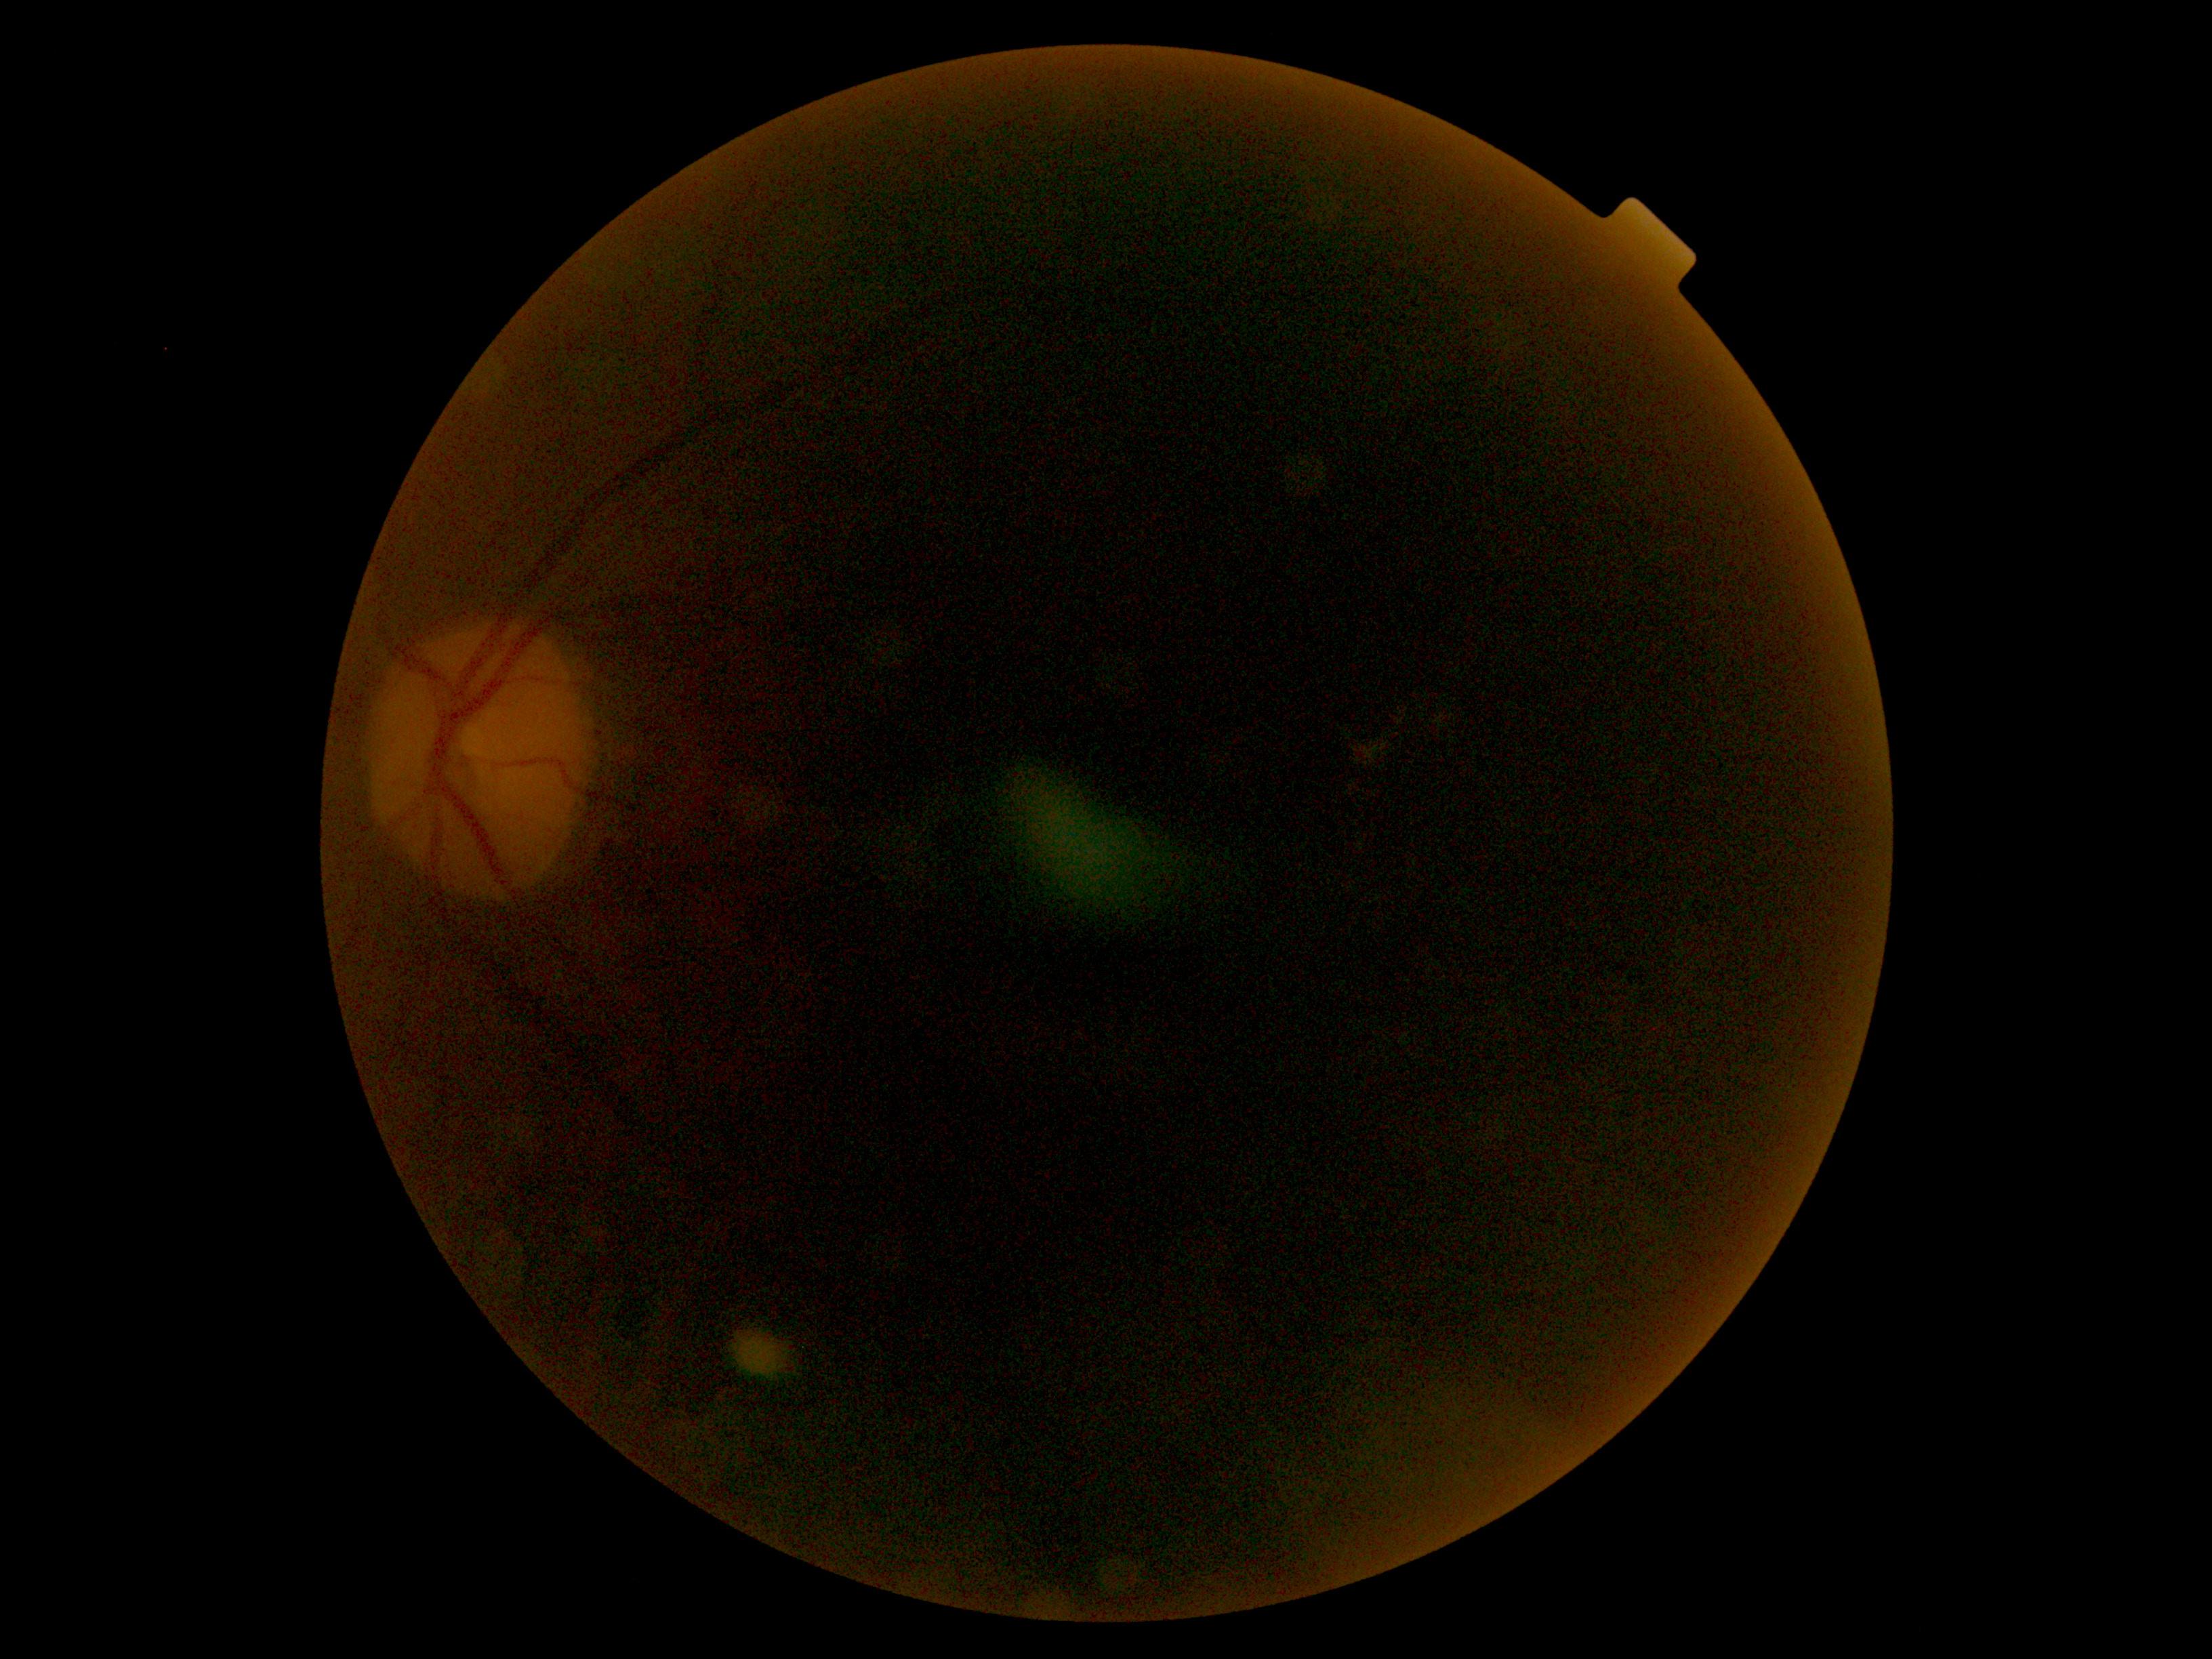

Diabetic retinopathy (DR) is ungradable. Quality too poor to assess for DR.